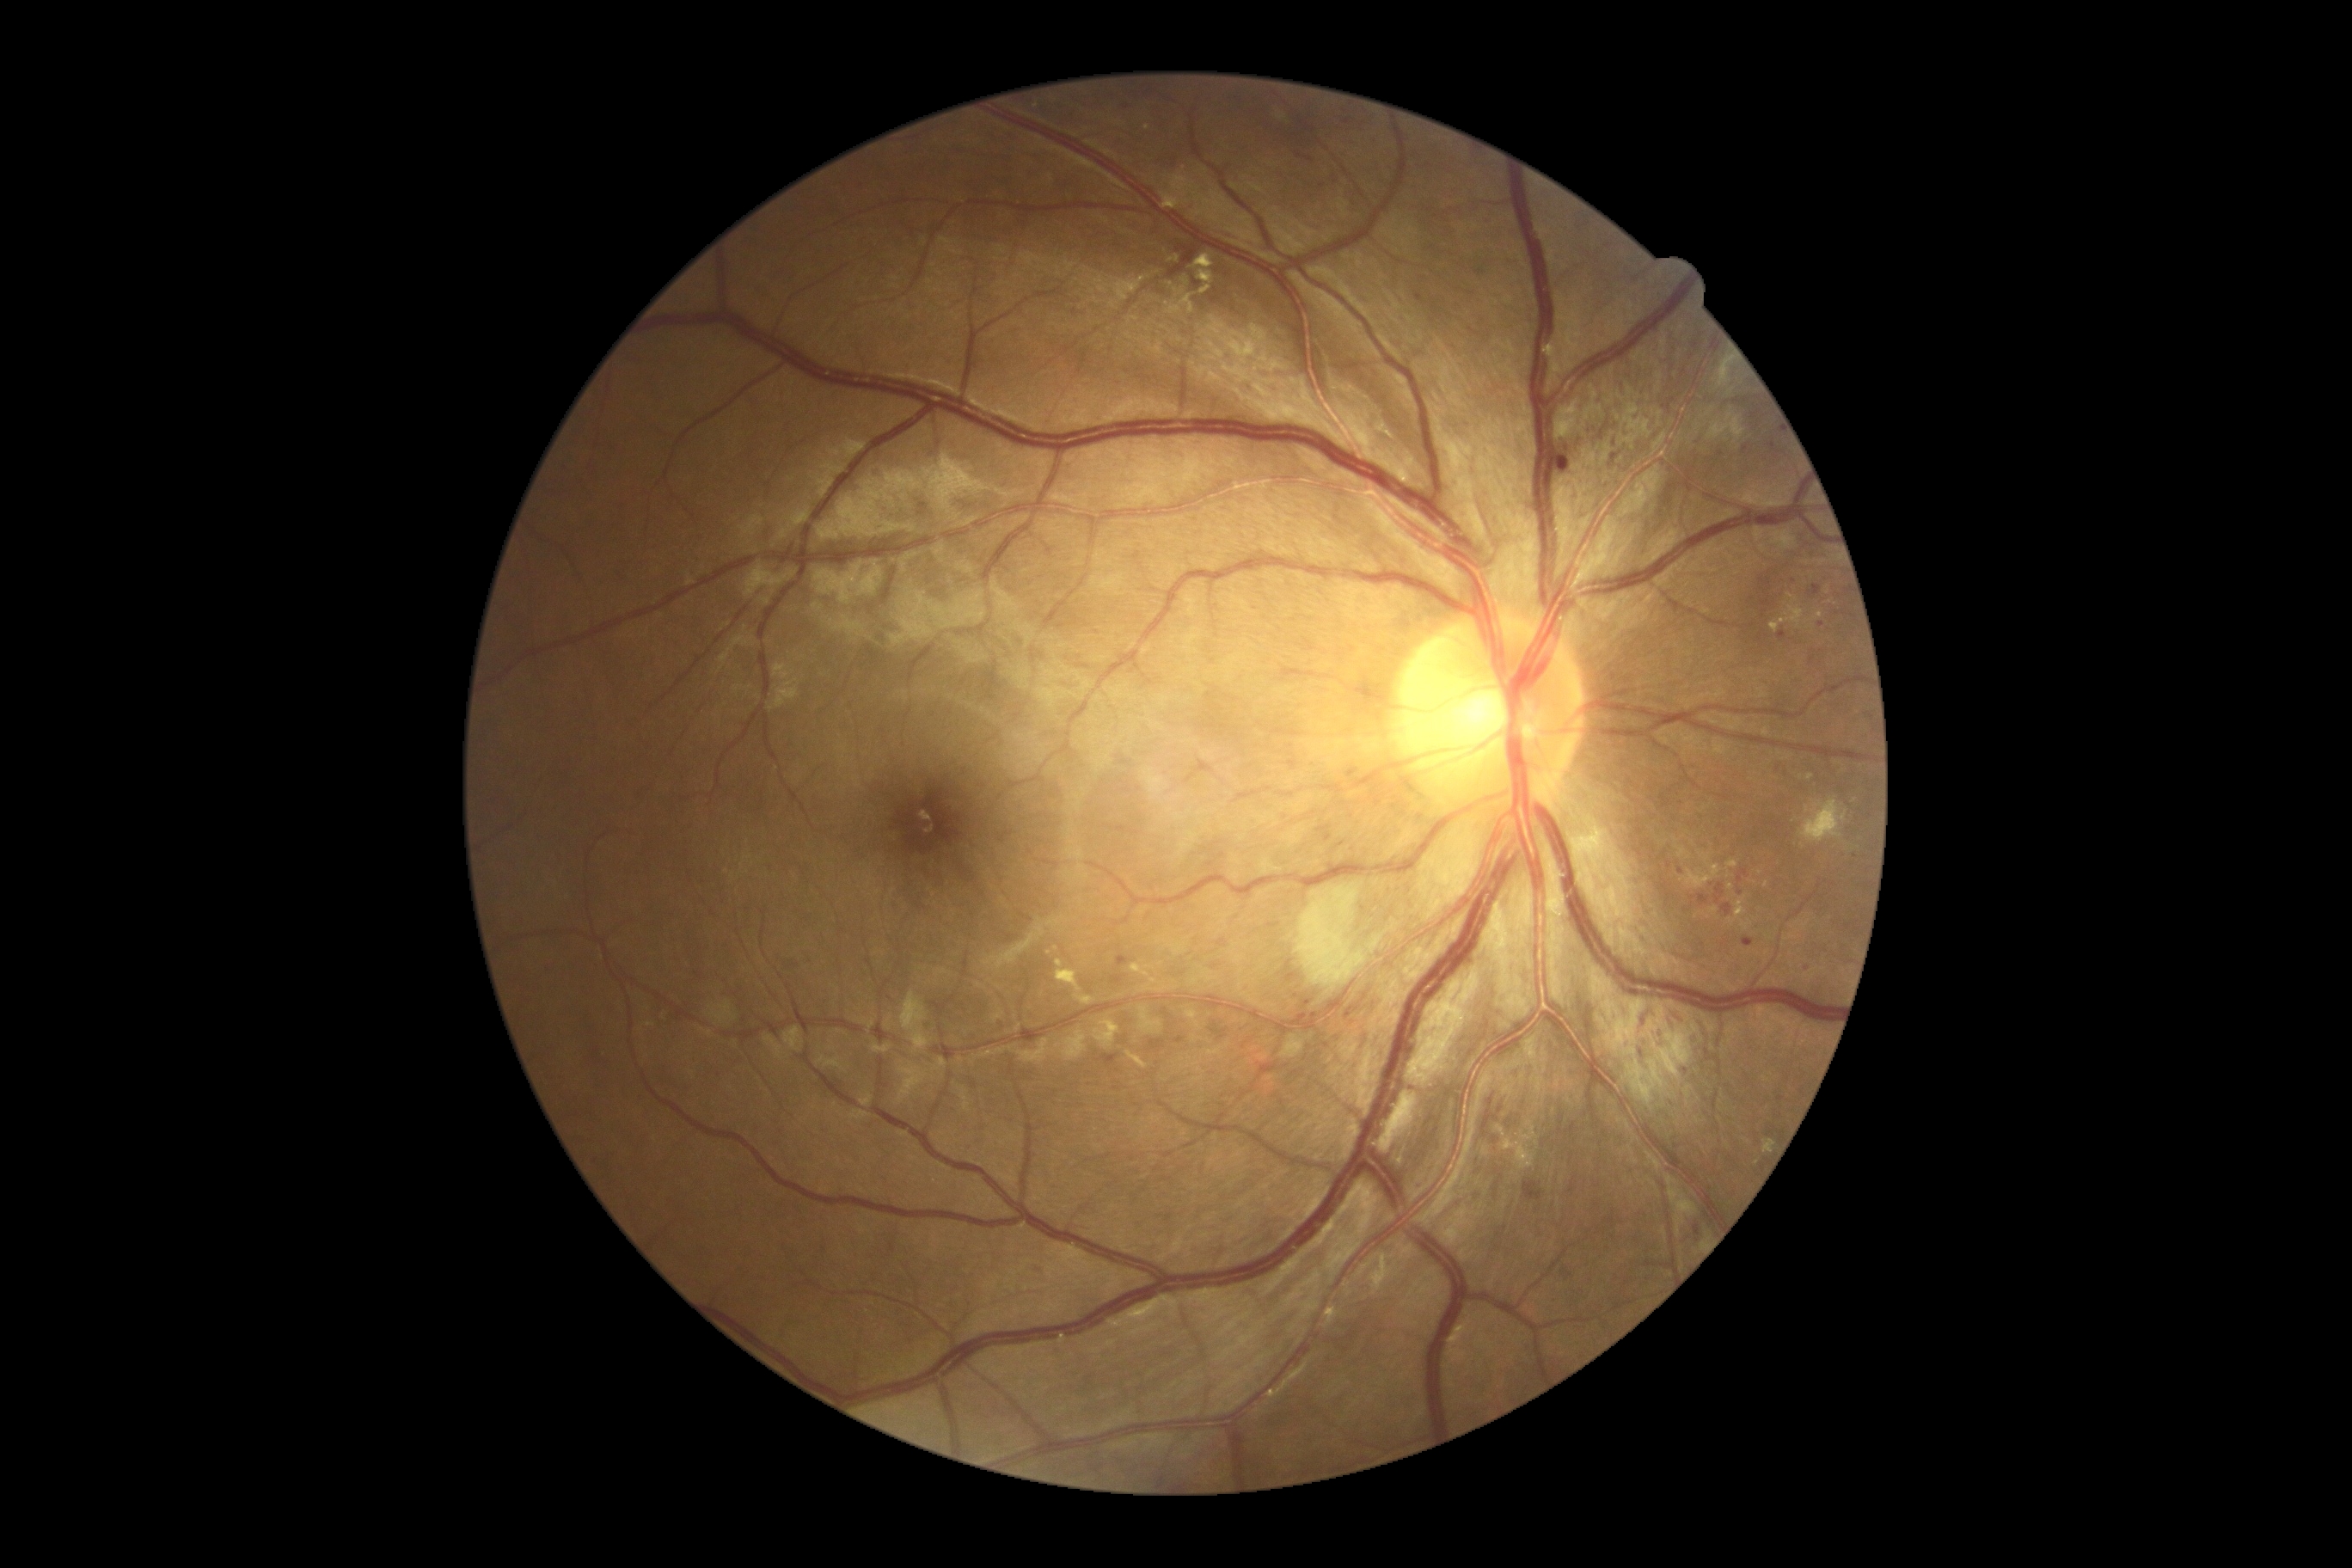 Diabetic retinopathy: moderate non-proliferative diabetic retinopathy (grade 2) — more than just microaneurysms but less than severe NPDR
Selected lesions:
• microaneurysms (subset): [left=1789, top=575, right=1794, bottom=589]; [left=1777, top=632, right=1784, bottom=646]; [left=1588, top=422, right=1596, bottom=436]; [left=1471, top=329, right=1479, bottom=336]; [left=1117, top=957, right=1130, bottom=967]; [left=1416, top=293, right=1424, bottom=303]; [left=1099, top=1055, right=1118, bottom=1067]; [left=1739, top=441, right=1746, bottom=453]; [left=1804, top=960, right=1813, bottom=972]; [left=1325, top=833, right=1332, bottom=842]
• Microaneurysms (small, approximate centers) near pt(1695, 345); pt(1772, 446); pt(1821, 625)
• hard exudates (subset): [left=1710, top=909, right=1718, bottom=916]; [left=1055, top=960, right=1082, bottom=993]; [left=1725, top=861, right=1739, bottom=869]; [left=1127, top=1051, right=1148, bottom=1070]; [left=1813, top=611, right=1823, bottom=620]; [left=1729, top=897, right=1748, bottom=926]; [left=1075, top=995, right=1096, bottom=1005]; [left=1767, top=618, right=1779, bottom=635]; [left=1185, top=1010, right=1201, bottom=1029]
• Hard exudates (small, approximate centers) near pt(1747, 1141); pt(1153, 981); pt(1049, 953); pt(1760, 872); pt(1809, 778); pt(1766, 884)